FOV: 50 degrees; Topcon TRC-50DX — 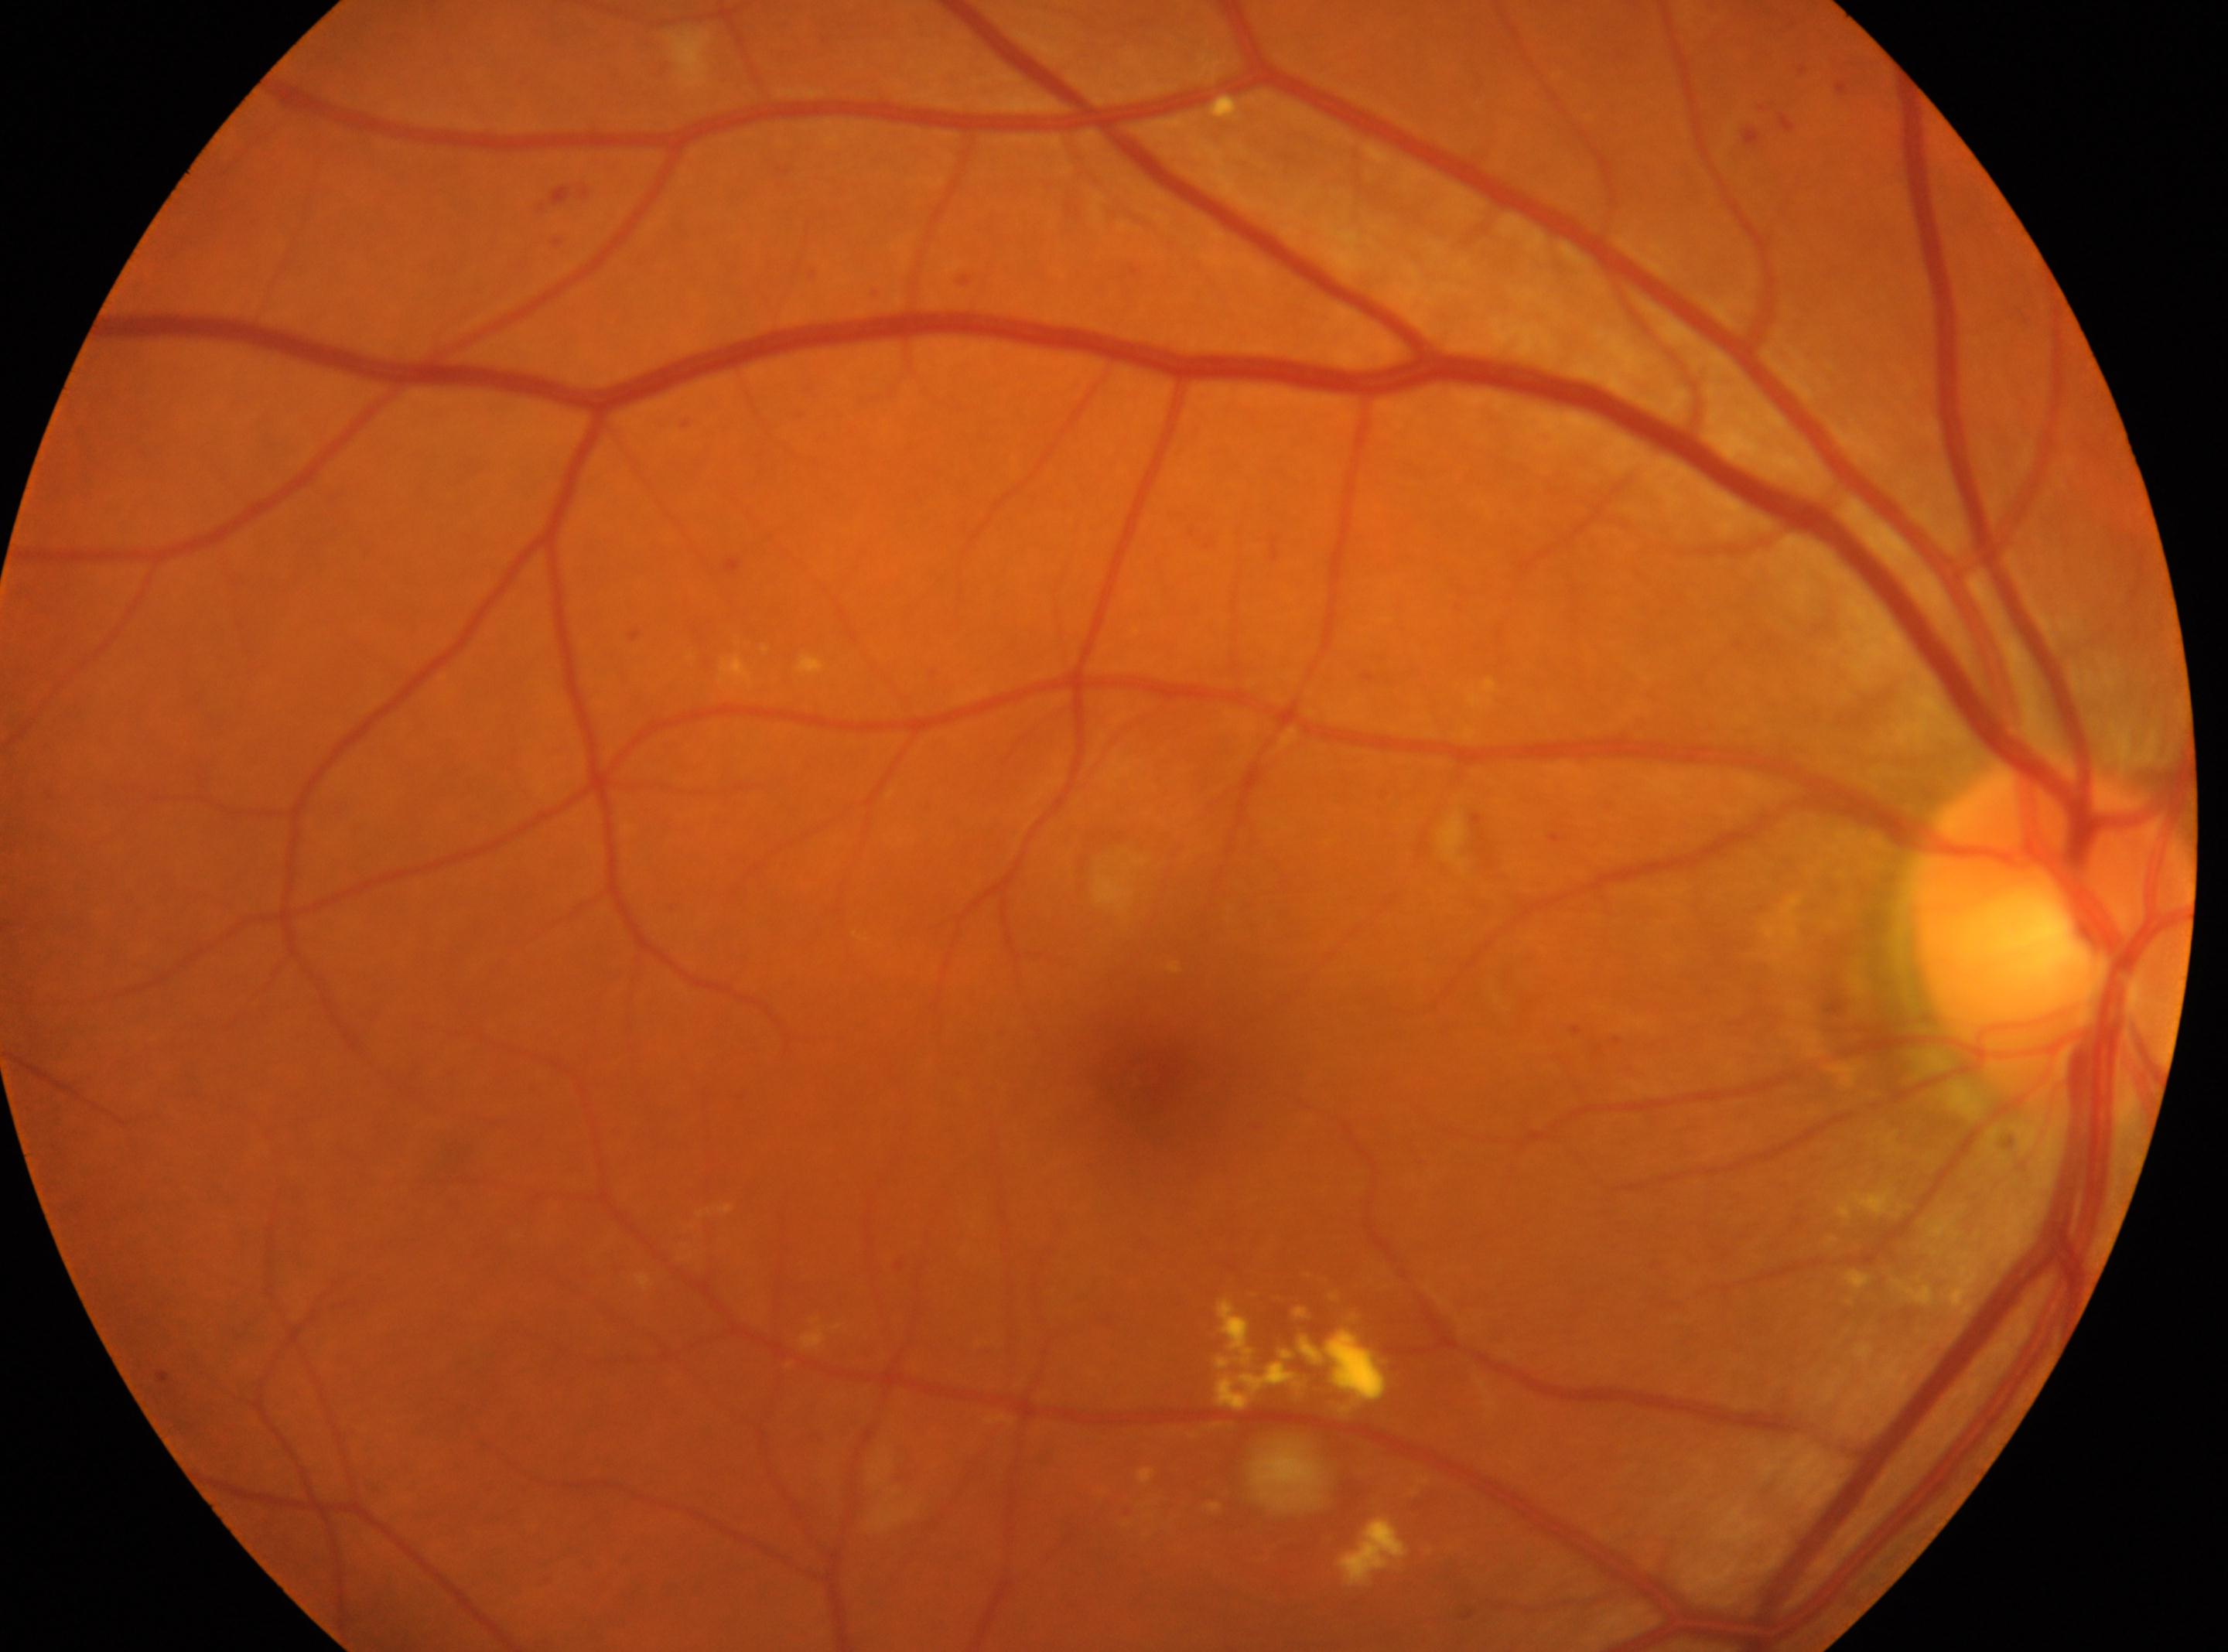
Annotations:
* laterality · oculus dexter
* the optic disc · (2053,940)
* macular center · (1146,1070)
* diabetic retinopathy severity · moderate non-proliferative diabetic retinopathy (grade 2) — more than just microaneurysms but less than severe NPDR